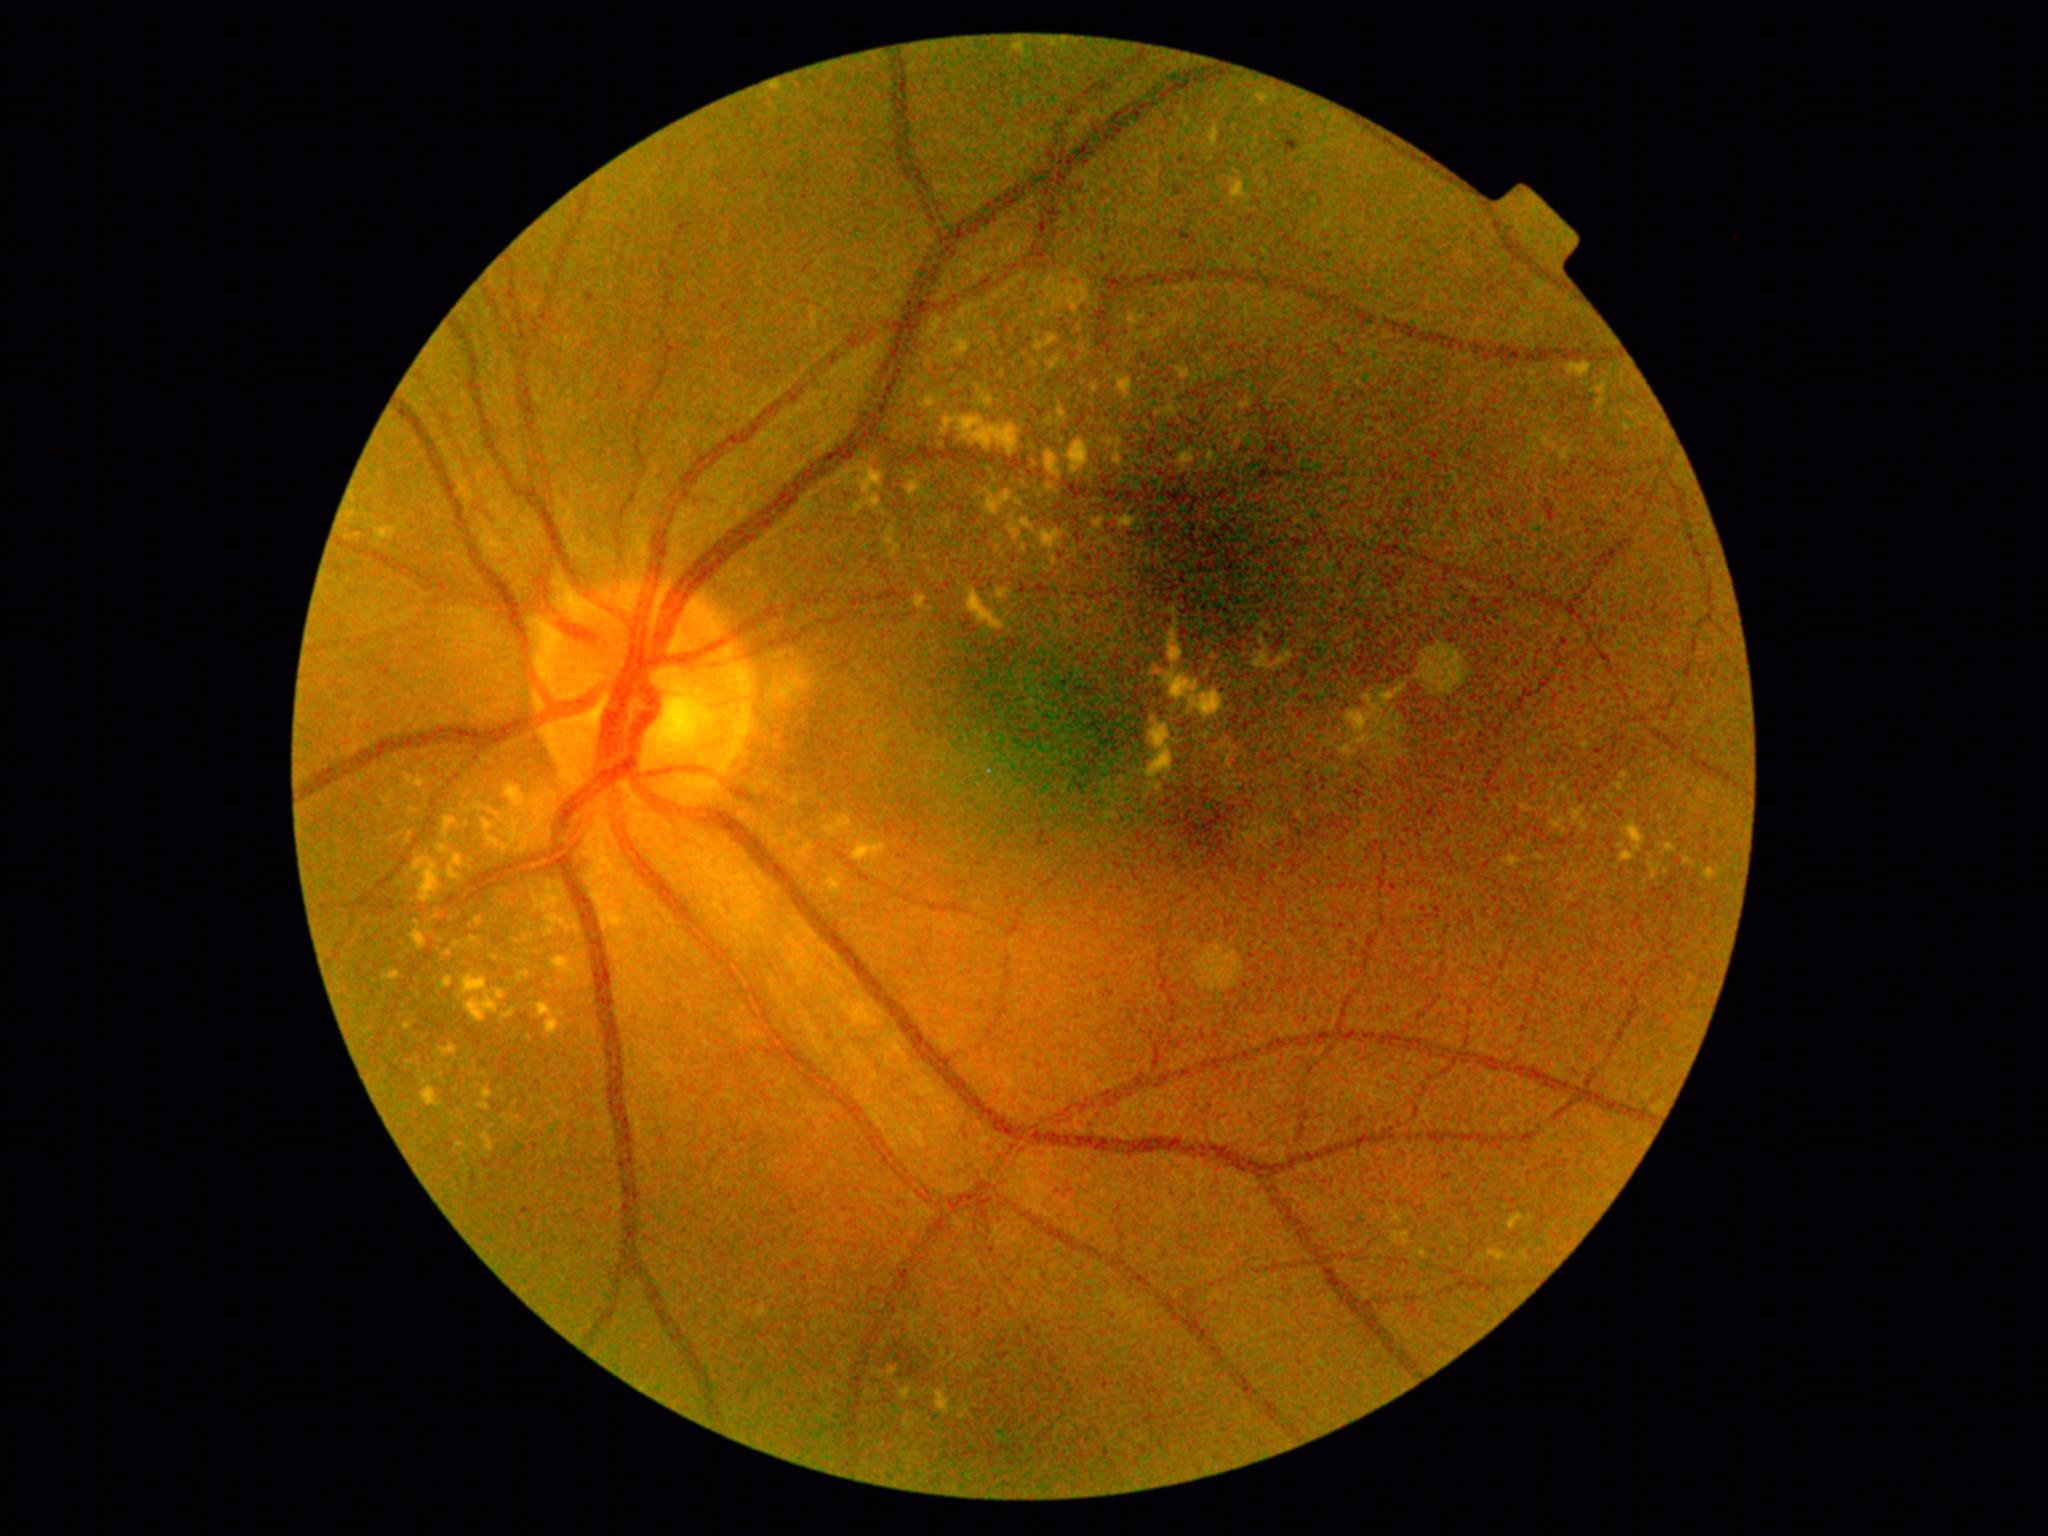 Diabetic retinopathy (DR): 2/4
Selected lesions:
hard exudates (EXs) (more not shown): [x1=1394, y1=1233, x2=1410, y2=1246] | [x1=467, y1=998, x2=497, y2=1021] | [x1=1582, y1=822, x2=1588, y2=831] | [x1=1562, y1=450, x2=1570, y2=461] | [x1=1212, y1=129, x2=1219, y2=146] | [x1=439, y1=845, x2=447, y2=854] | [x1=1033, y1=461, x2=1037, y2=470] | [x1=1056, y1=408, x2=1065, y2=415] | [x1=1345, y1=695, x2=1381, y2=745] | [x1=1032, y1=341, x2=1042, y2=351] | [x1=1022, y1=519, x2=1032, y2=533] | [x1=506, y1=786, x2=525, y2=808] | [x1=343, y1=528, x2=358, y2=546]
Small EXs near <pt>1527,807</pt> | <pt>460,1145</pt> | <pt>1666,873</pt> | <pt>1564,789</pt> | <pt>1625,775</pt>